Intraocular pressure (IOP) by pneumatic tonometry: 14 mmHg:
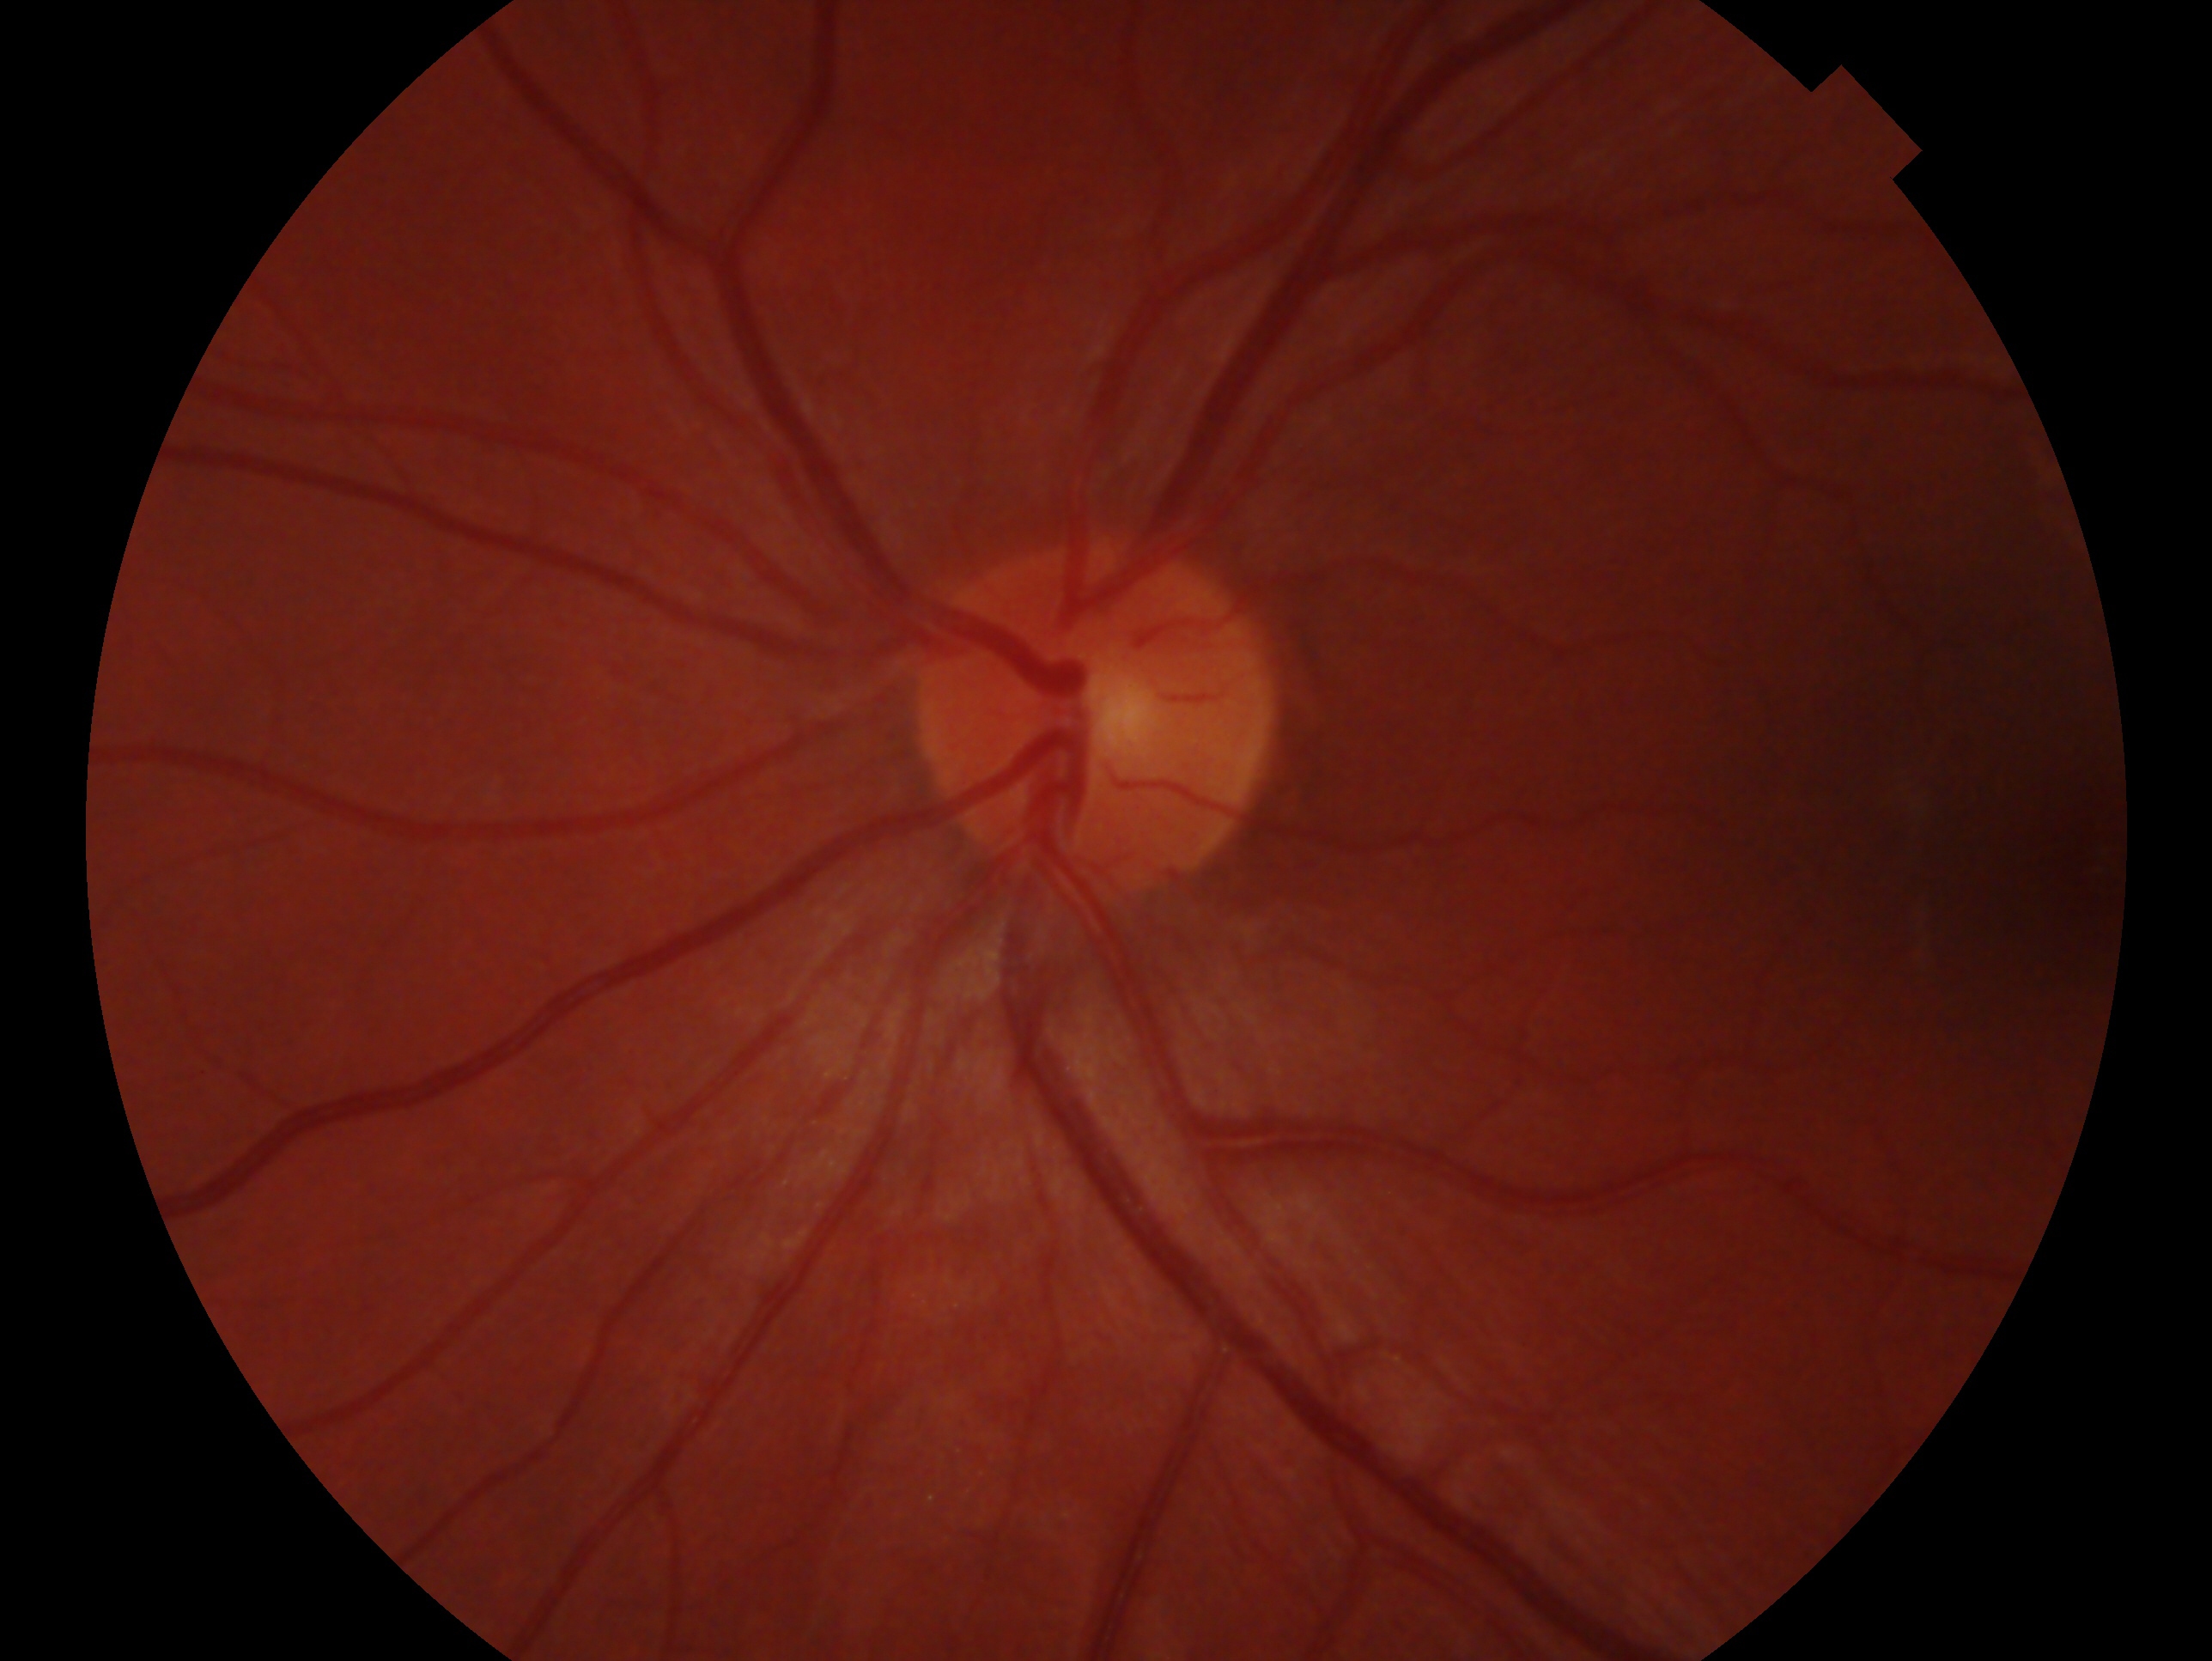

Imaged eye: oculus sinister.
Glaucoma assessment: no evidence of glaucoma.